45° field of view:
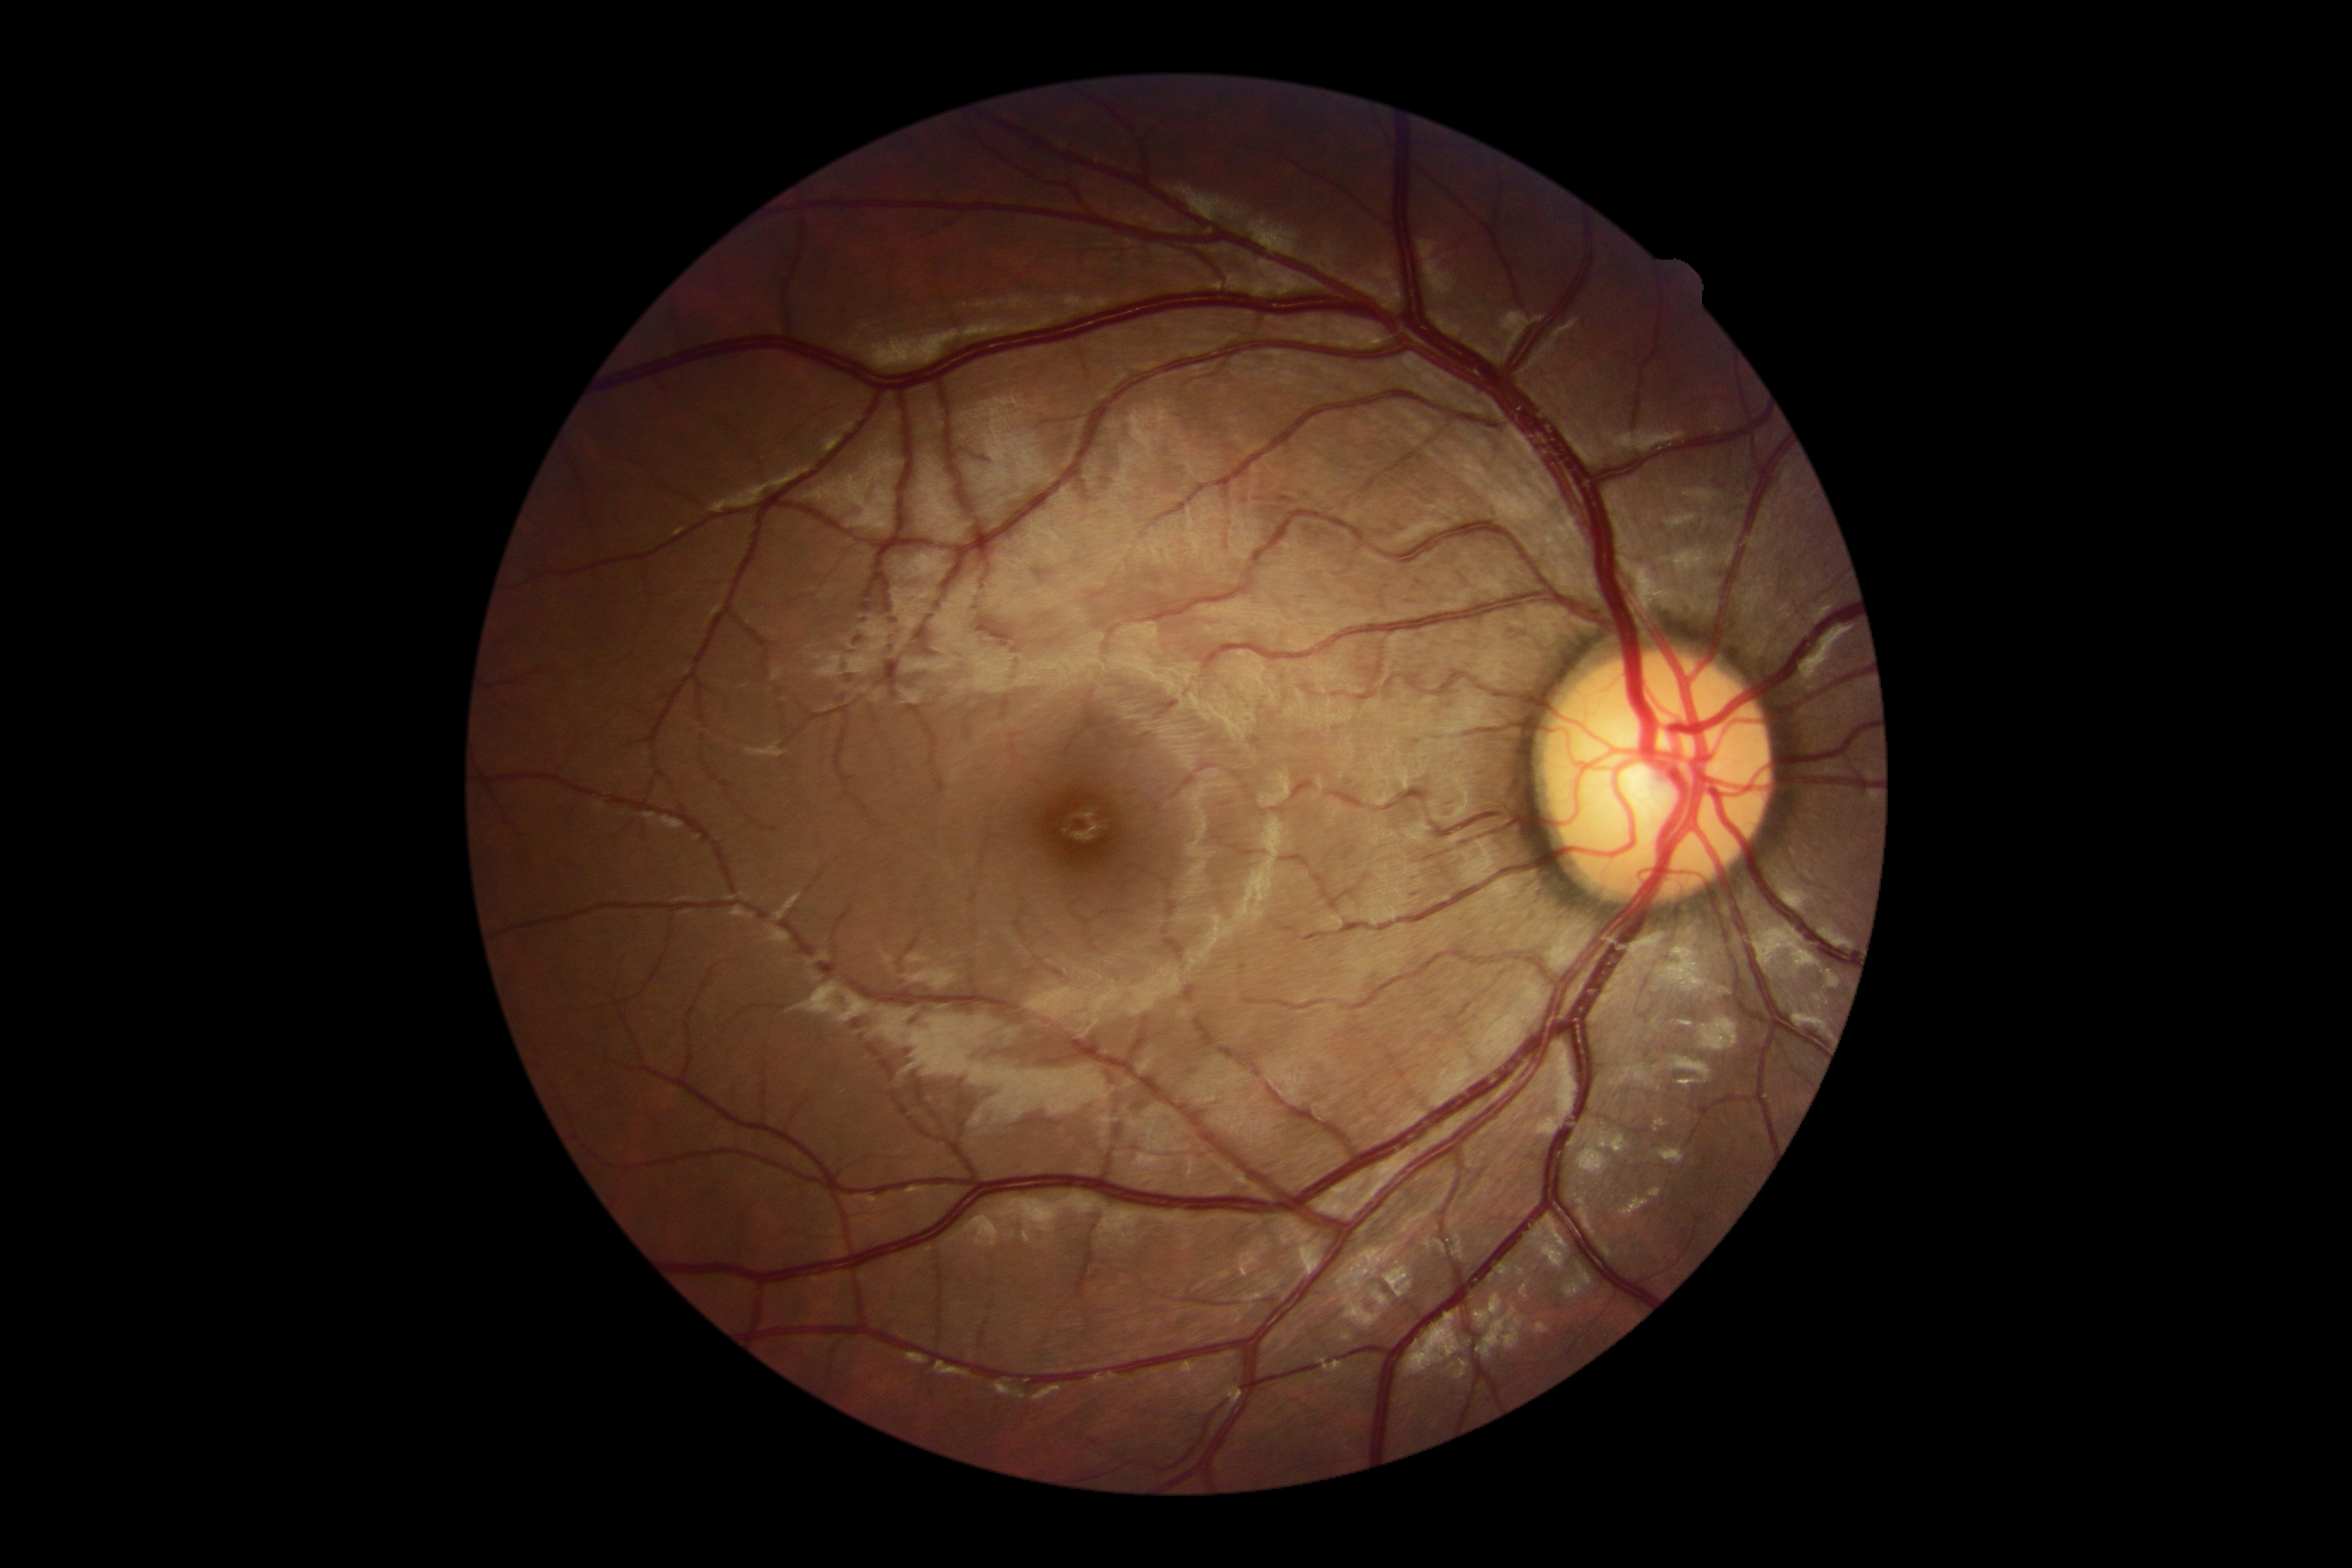

Diabetic retinopathy (DR) is 0/4 — no visible signs of diabetic retinopathy.